2048 by 1536 pixels. Color fundus photograph.
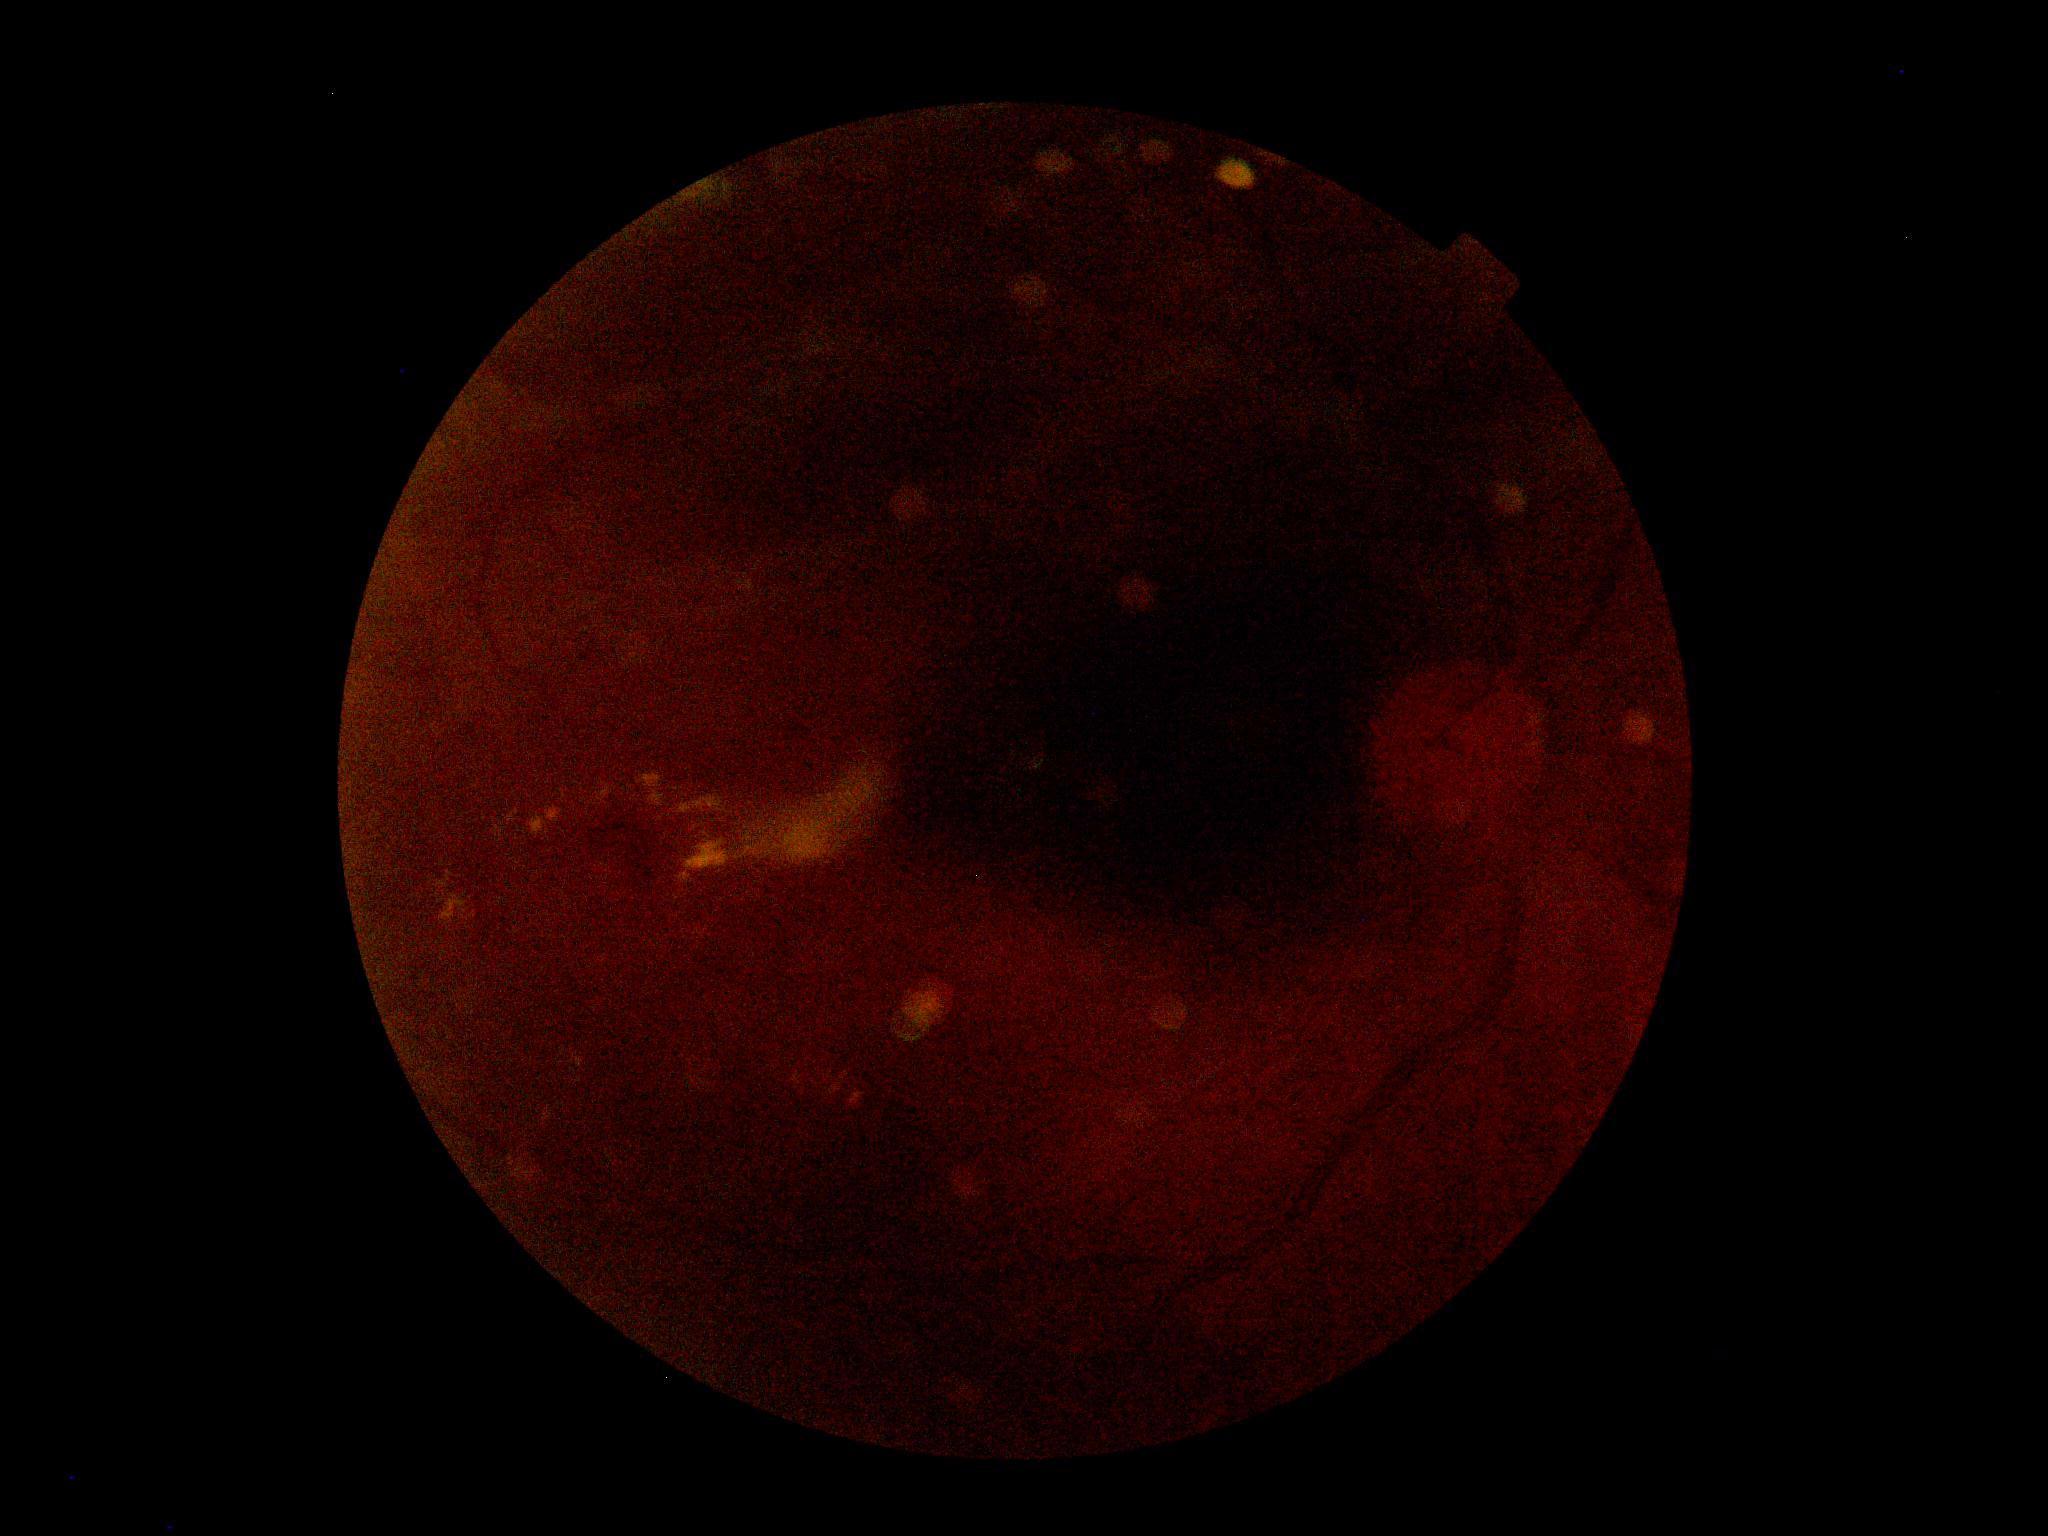

Retinopathy grade is moderate non-proliferative diabetic retinopathy (2).